45° FOV: 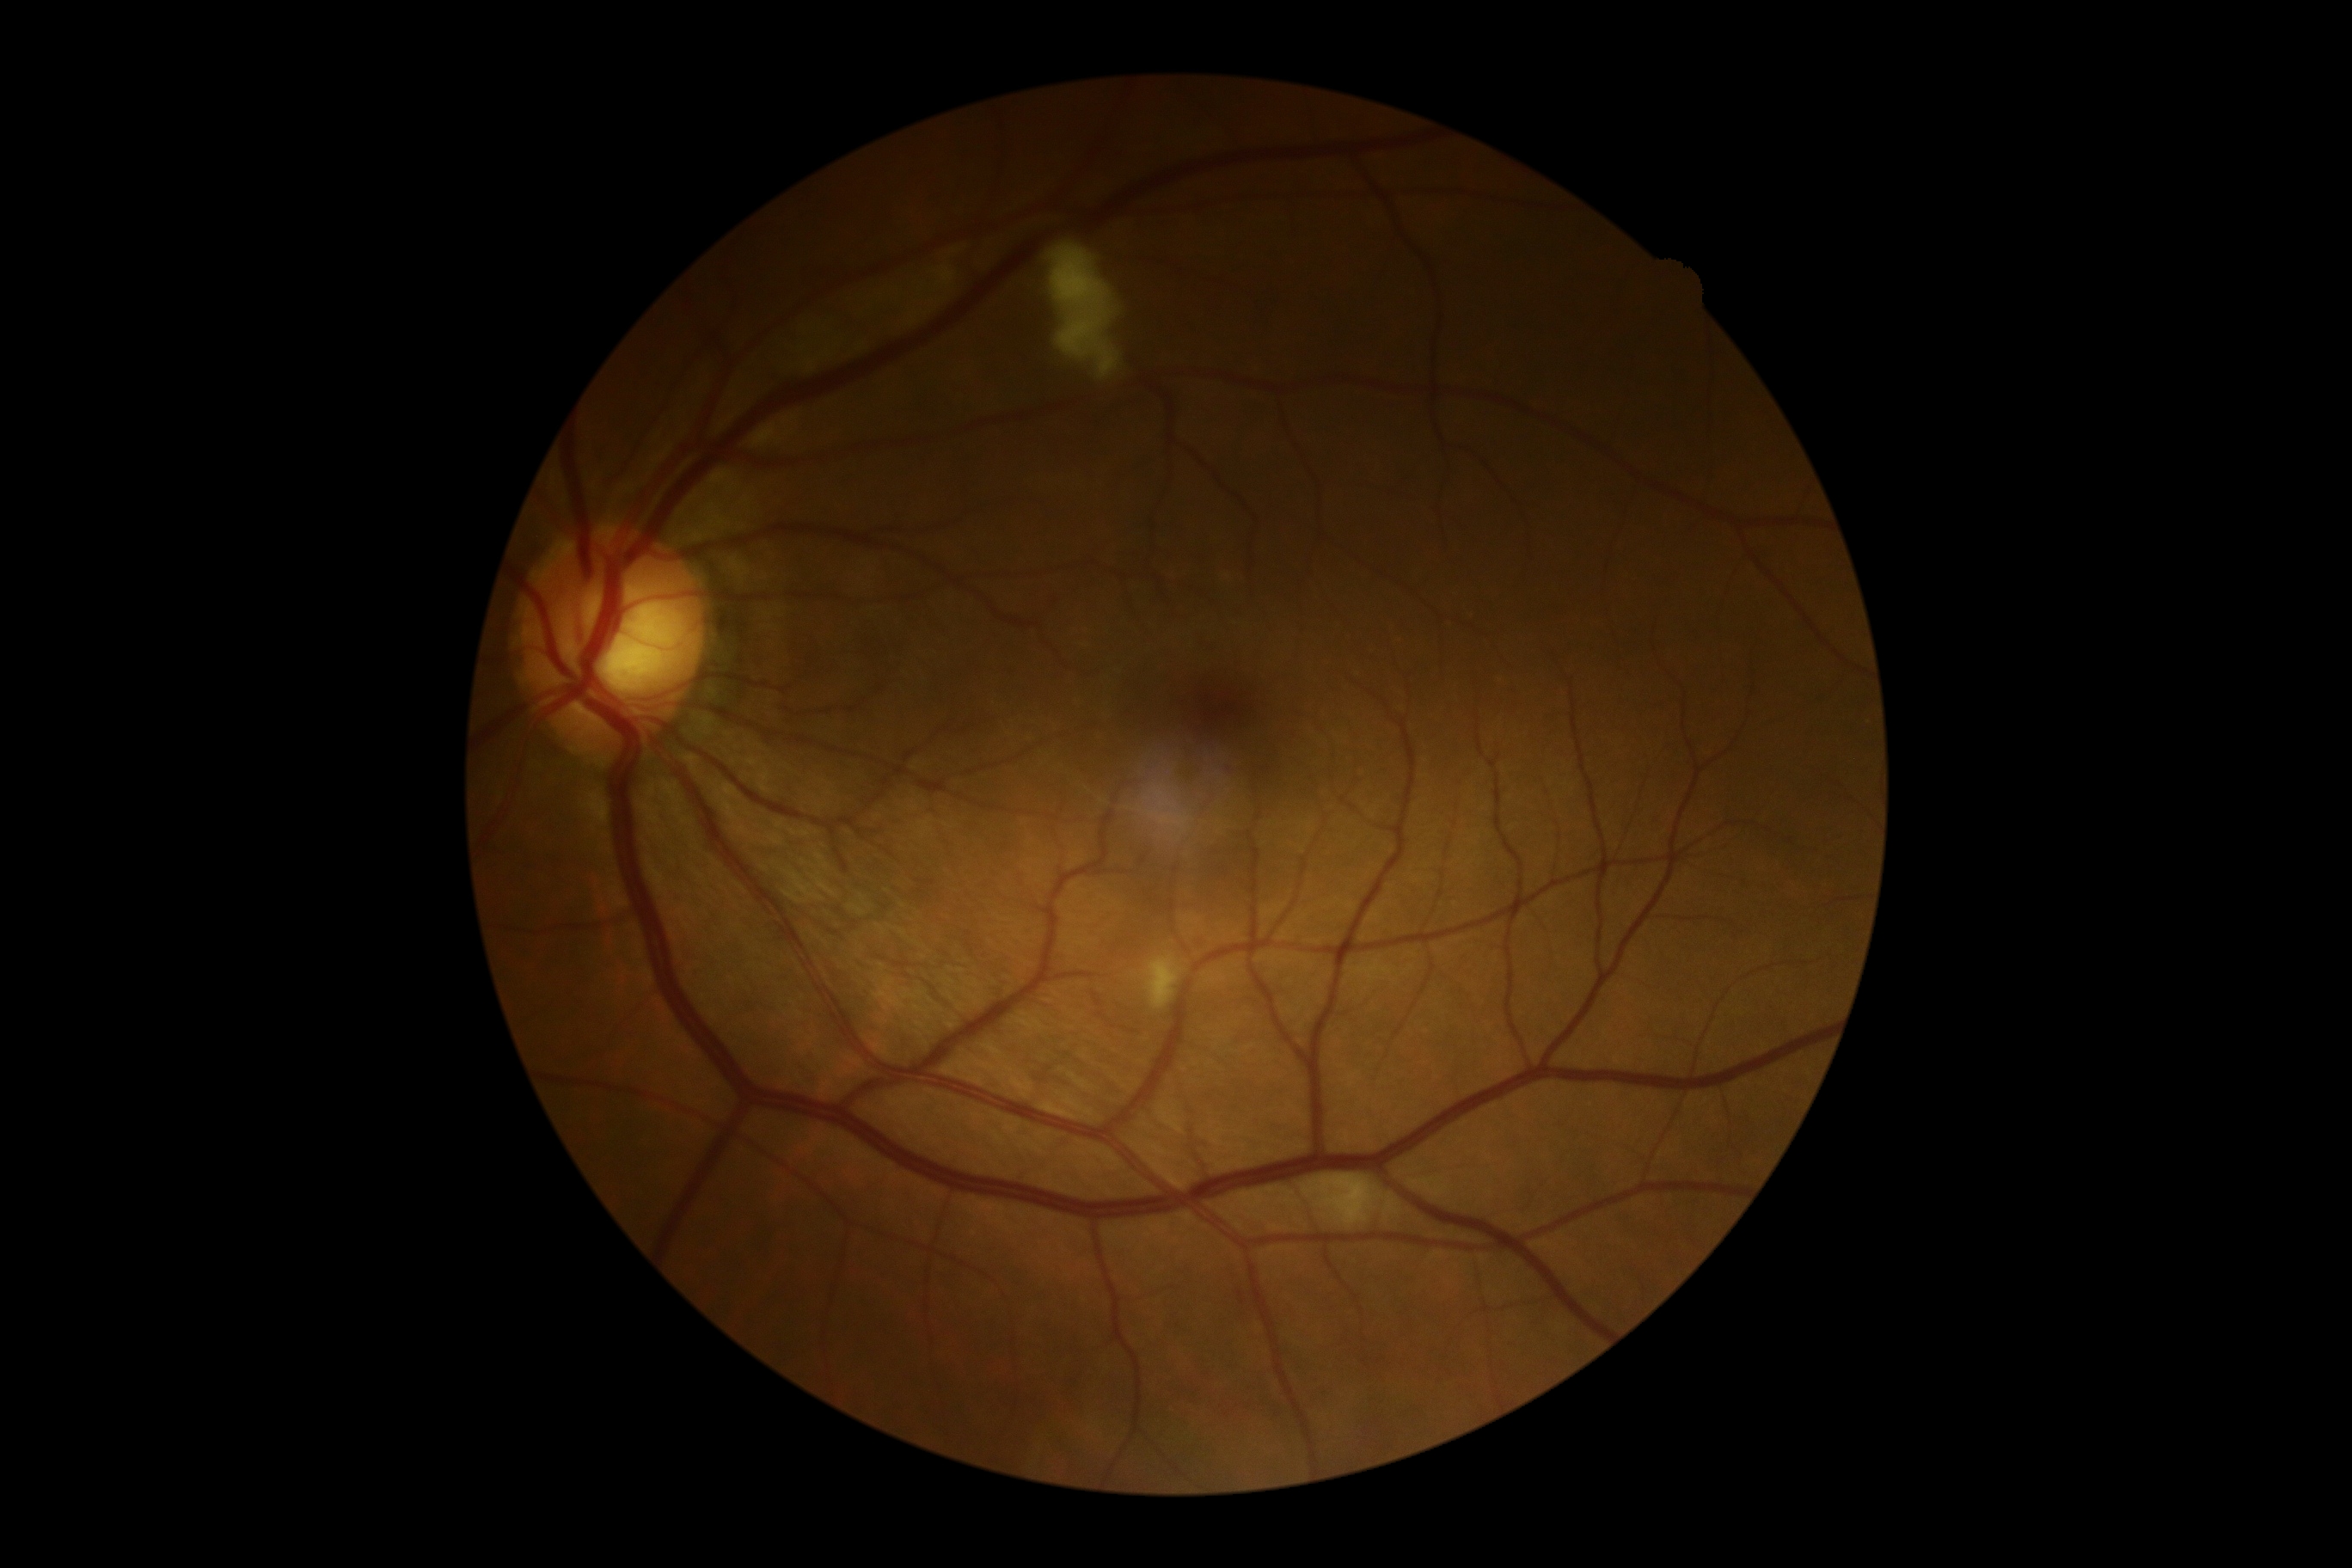

DR: grade 2 (moderate NPDR).